Fundus photo, FOV: 45 degrees, 2212x1659: 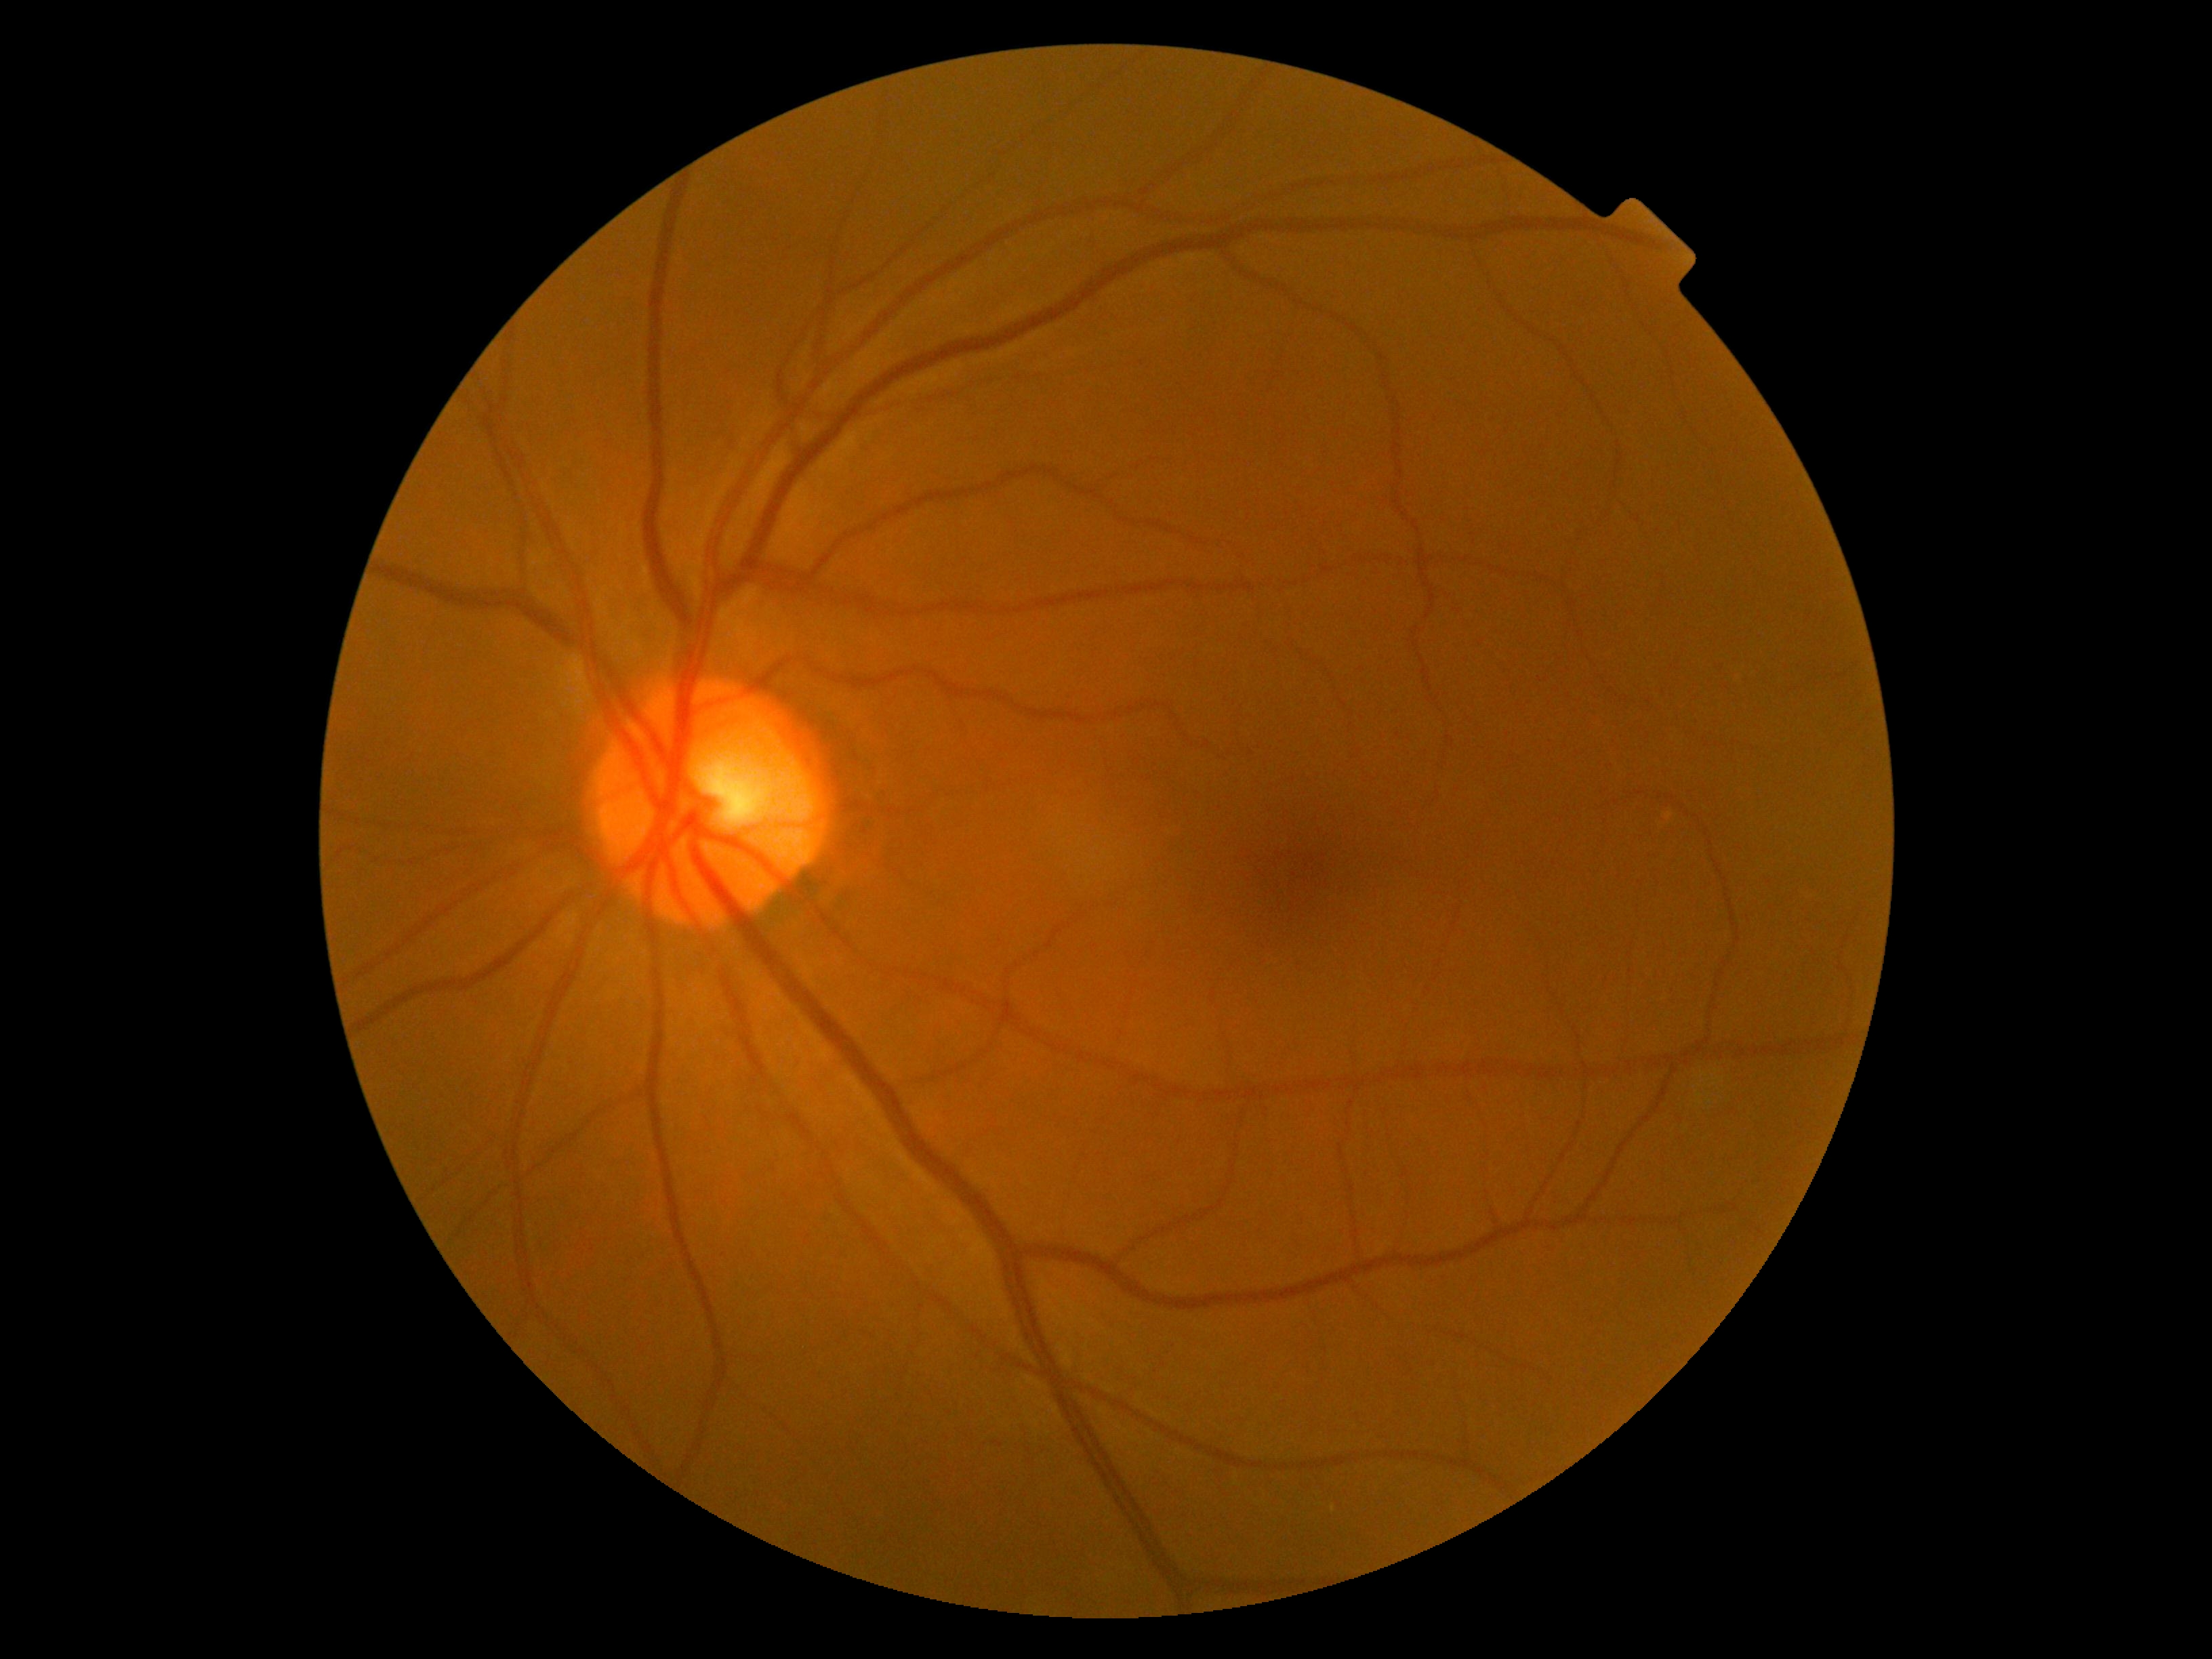

{
  "dr_grade": "grade 0",
  "dr_impression": "no signs of DR"
}